CFP.
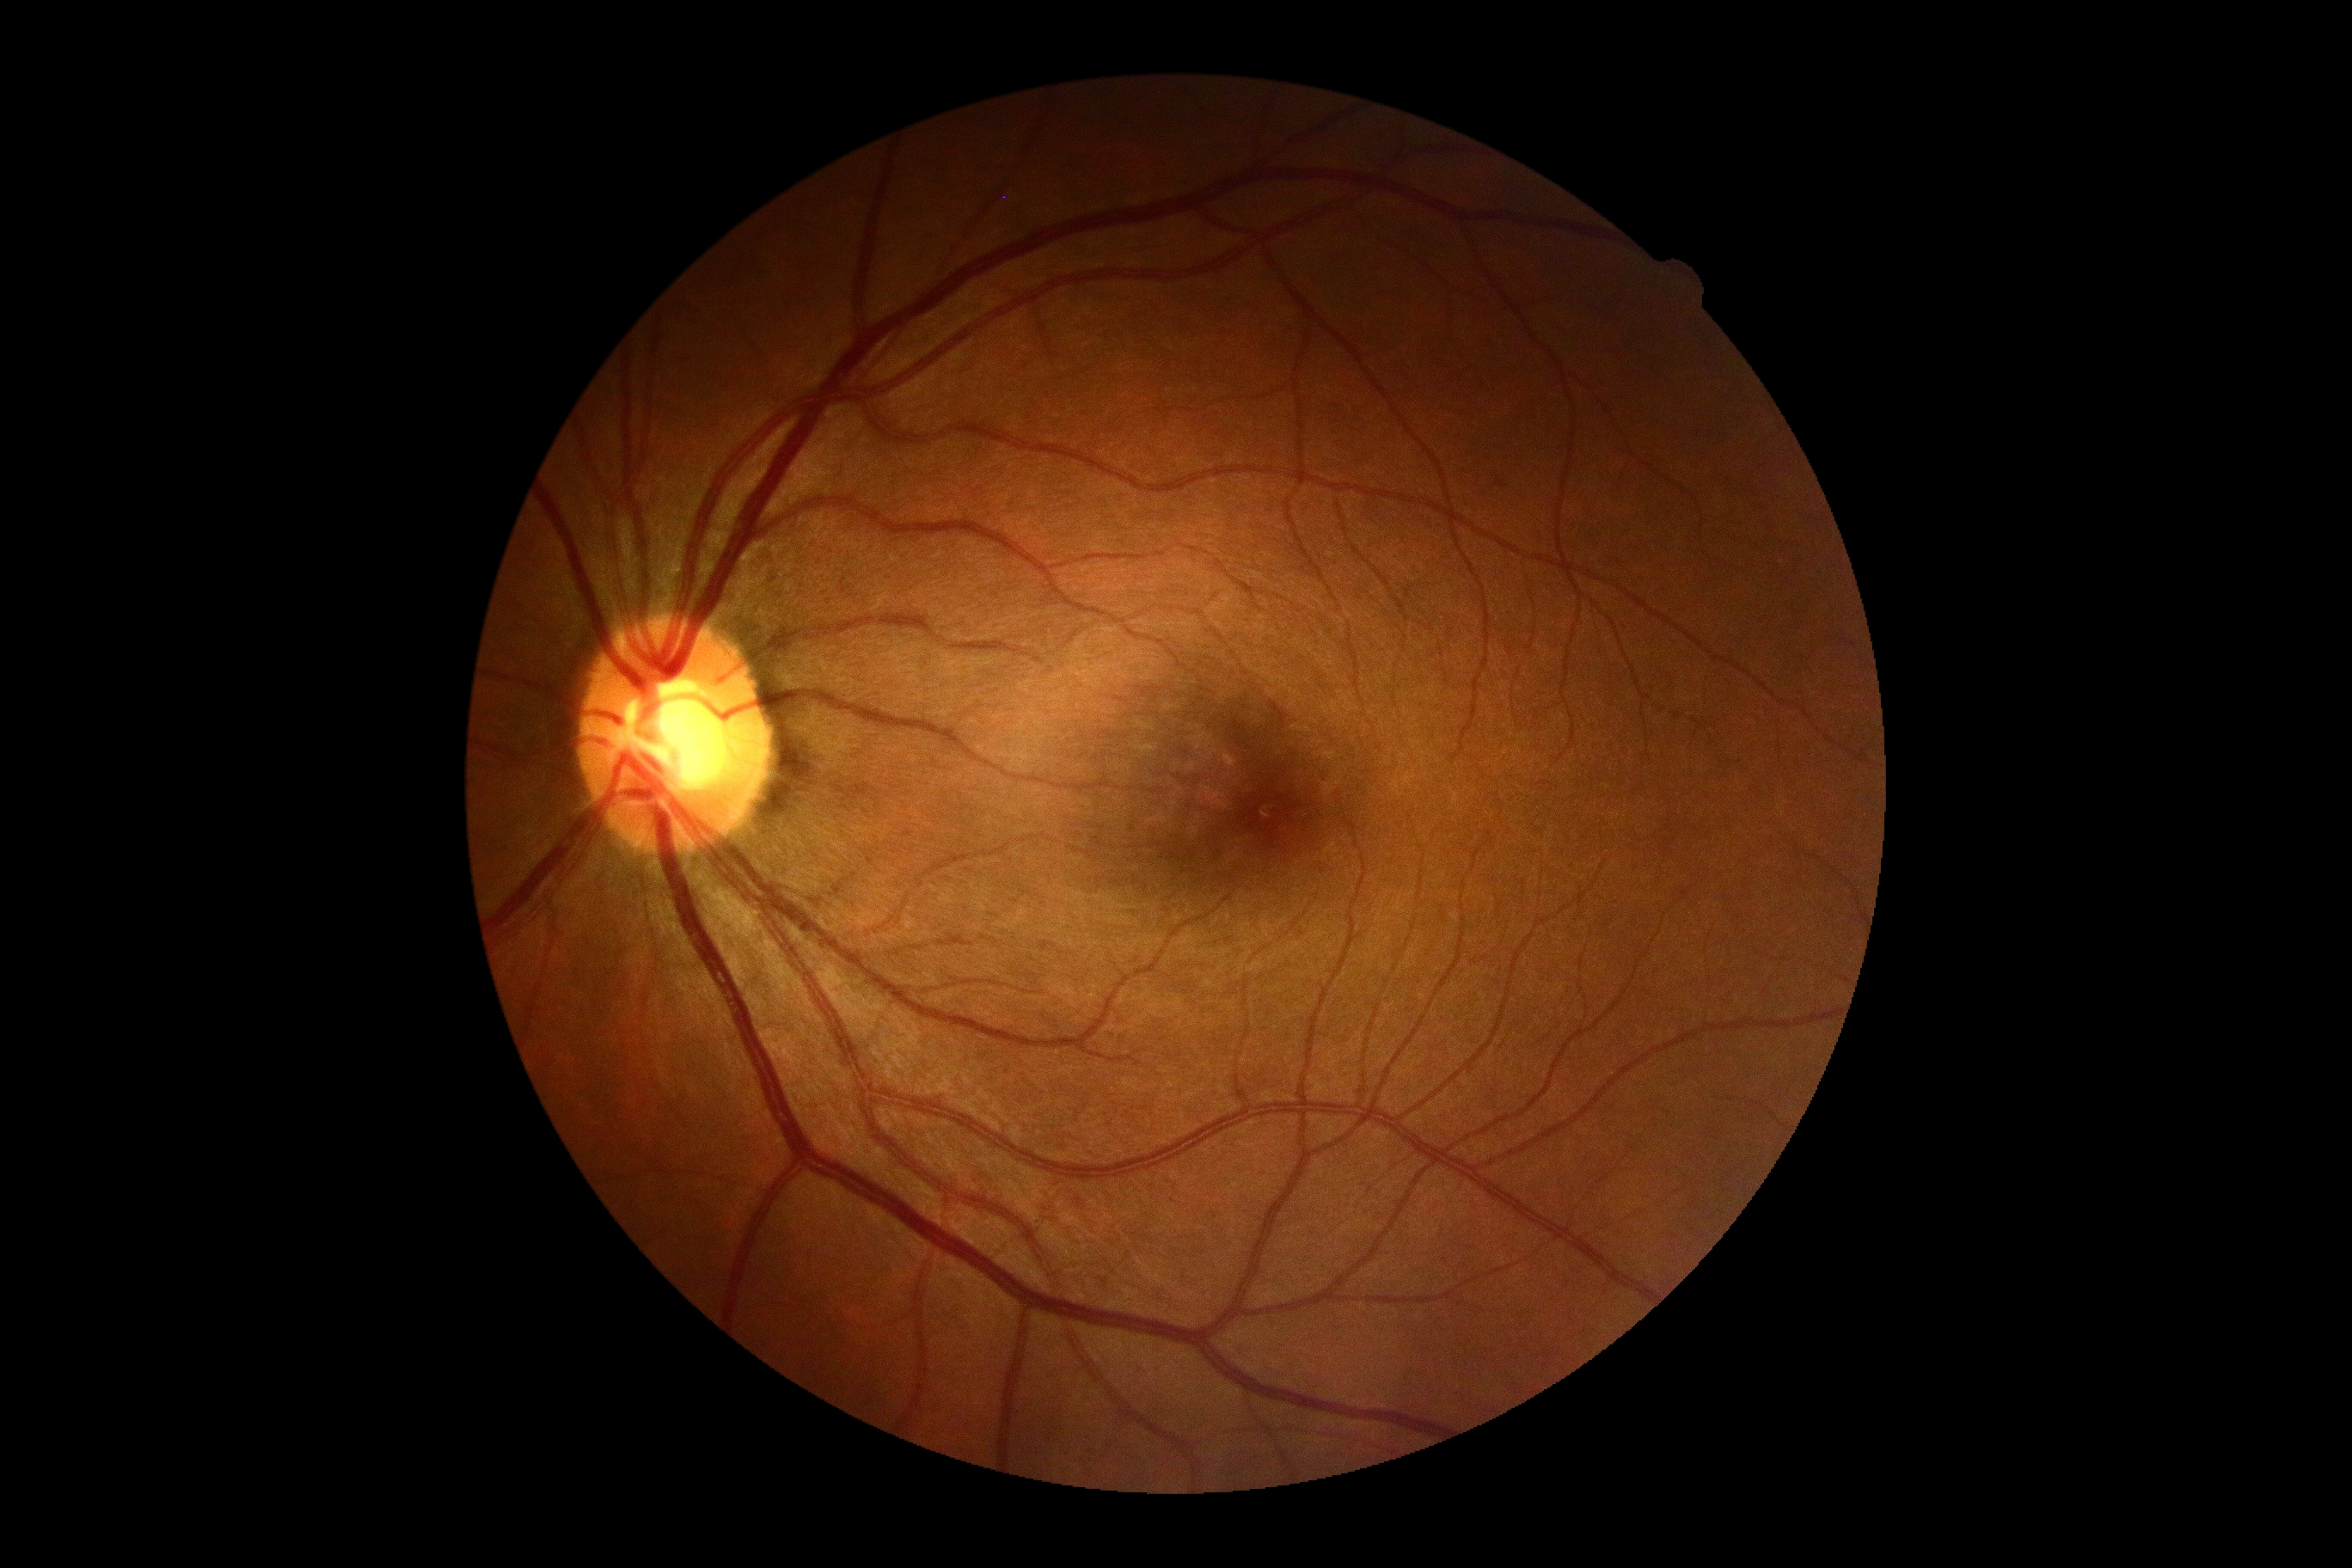

{
  "dr_grade": "grade 0 (no apparent retinopathy) — no visible signs of diabetic retinopathy"
}